2048 x 1536 pixels: 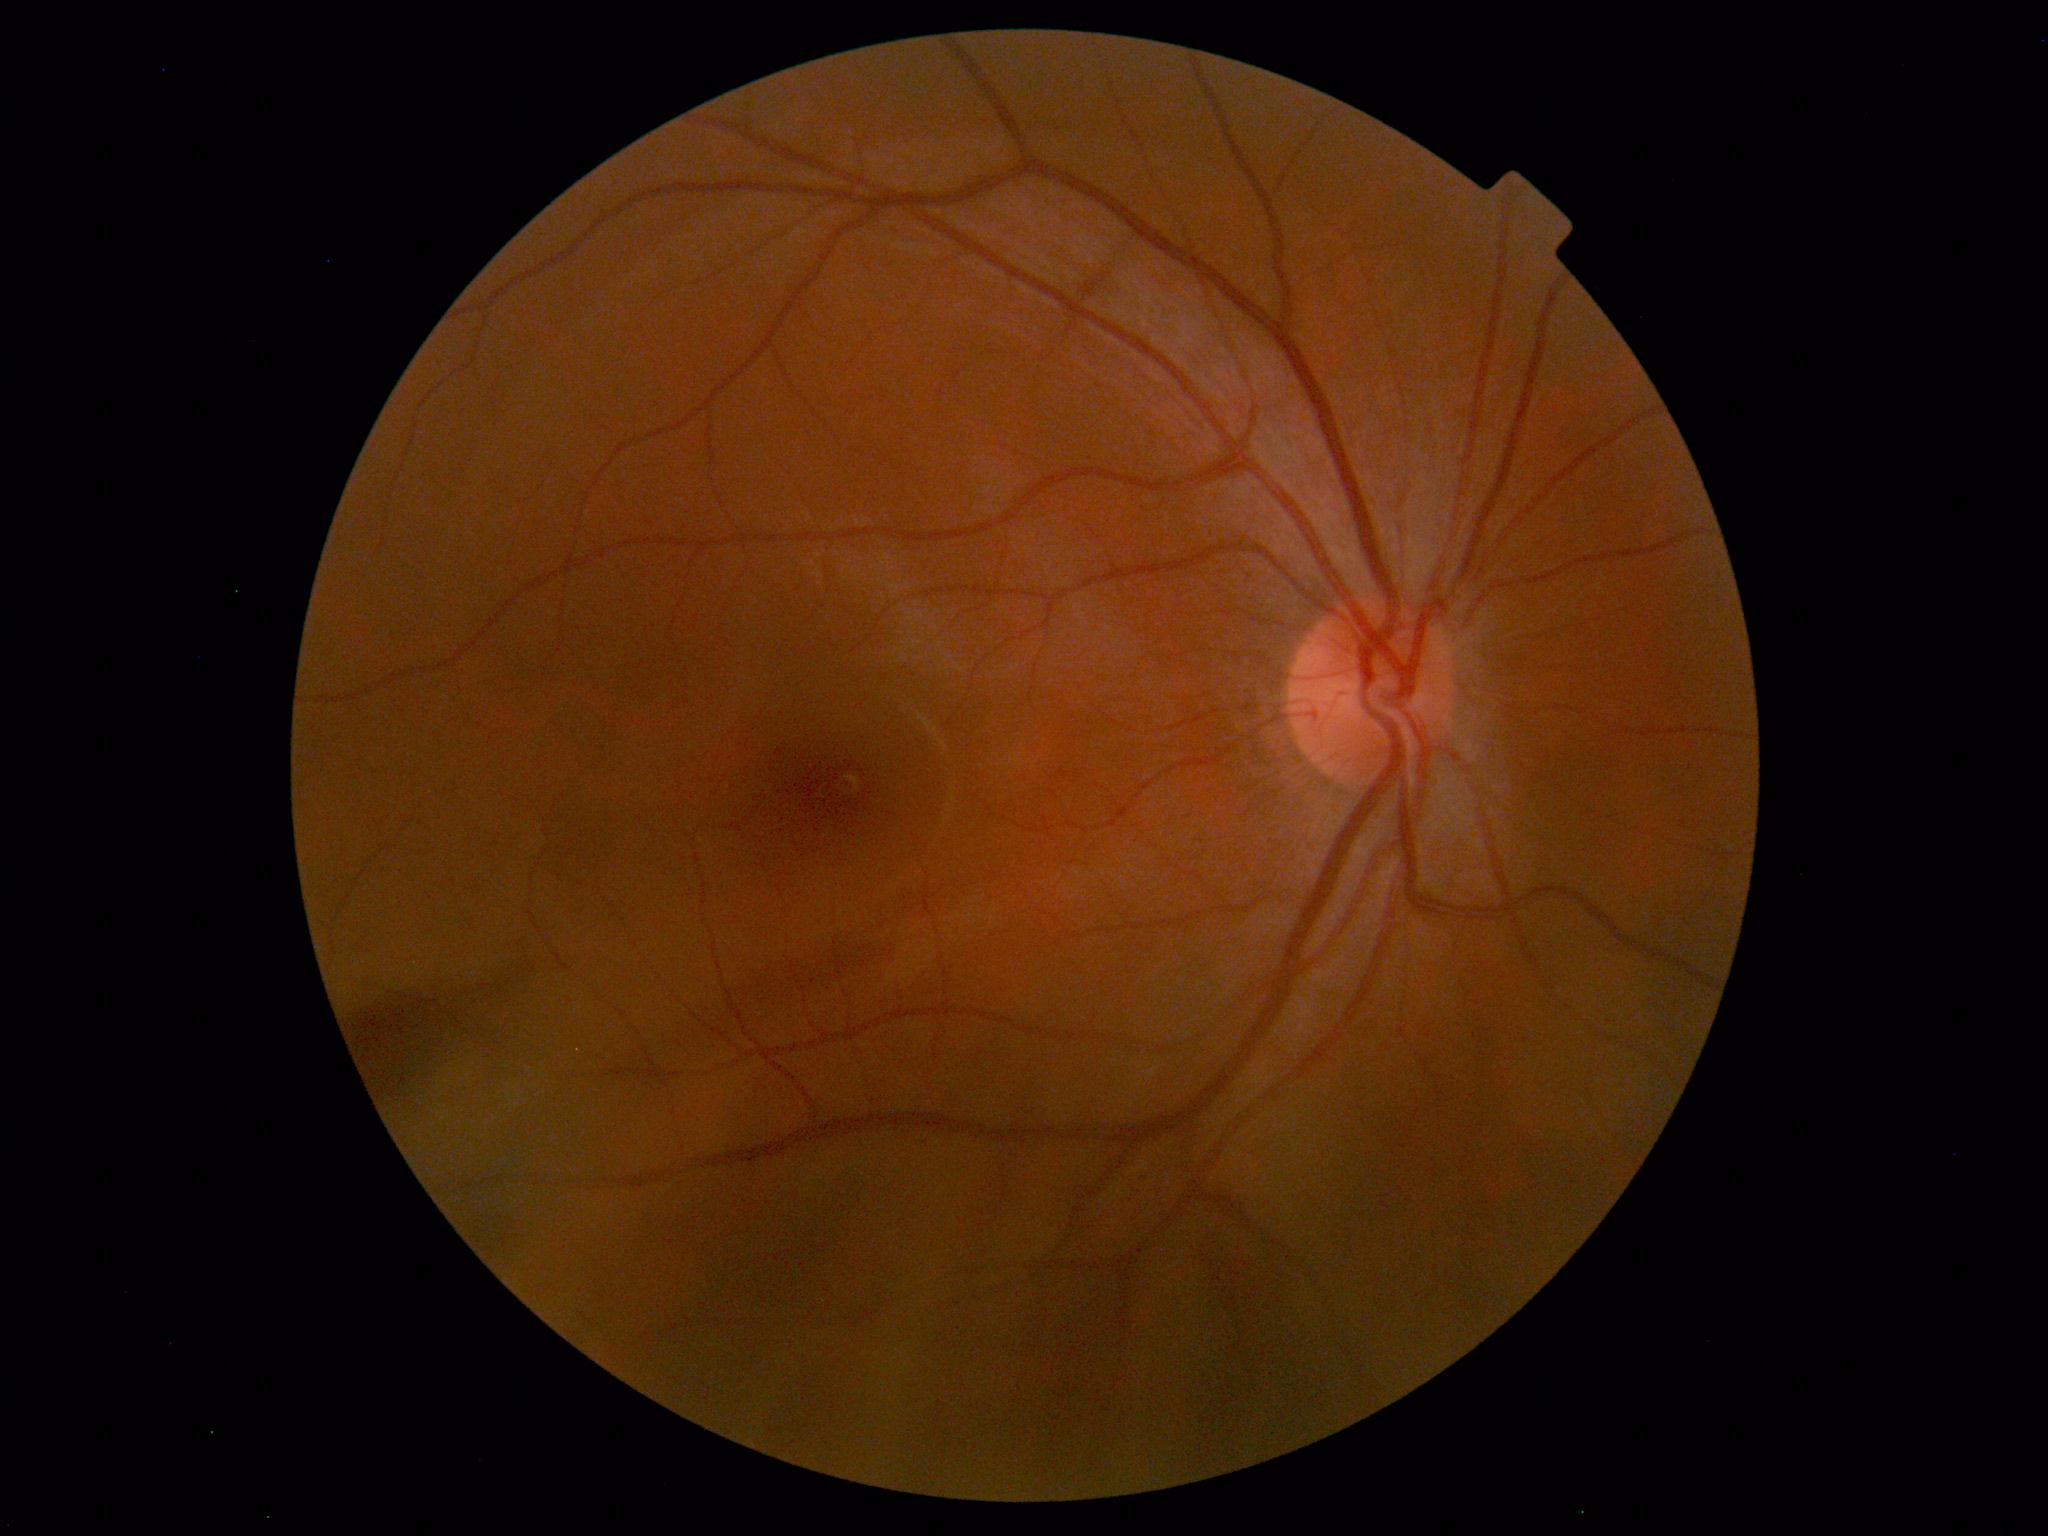 No abnormal findings on fundus examination.